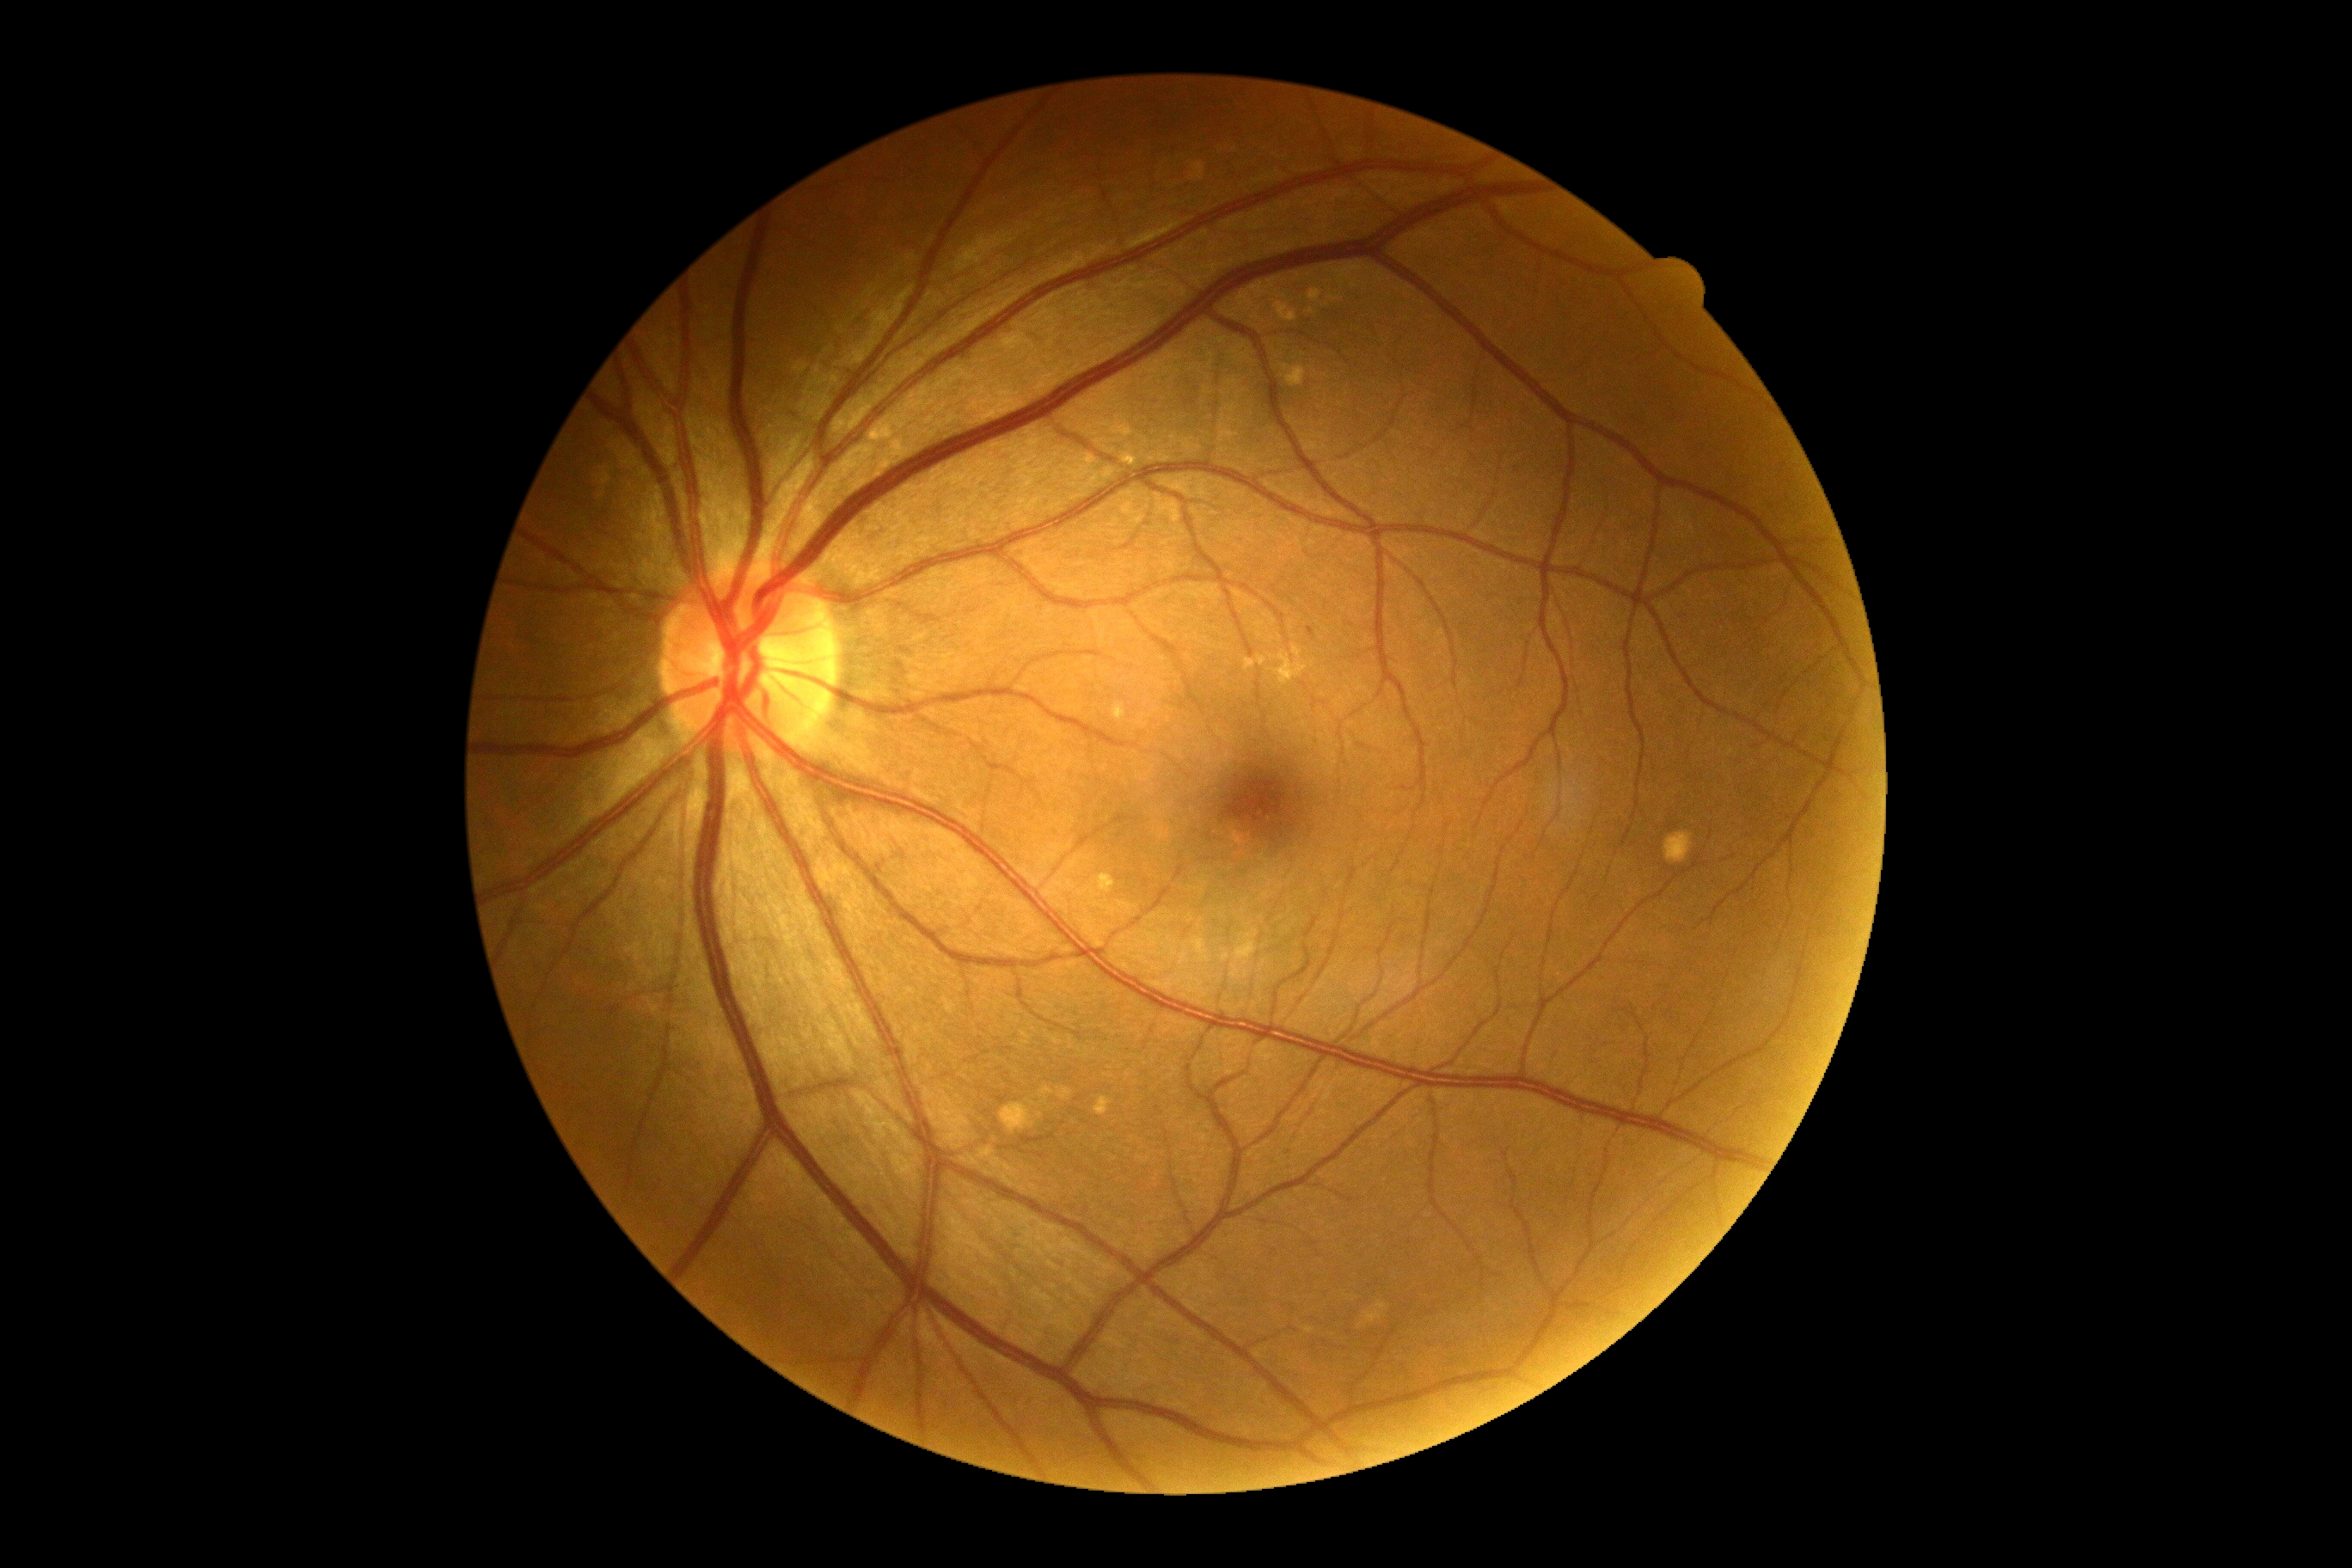
No apparent diabetic retinopathy. Diabetic retinopathy severity: no apparent diabetic retinopathy (grade 0).